Fundus photo: 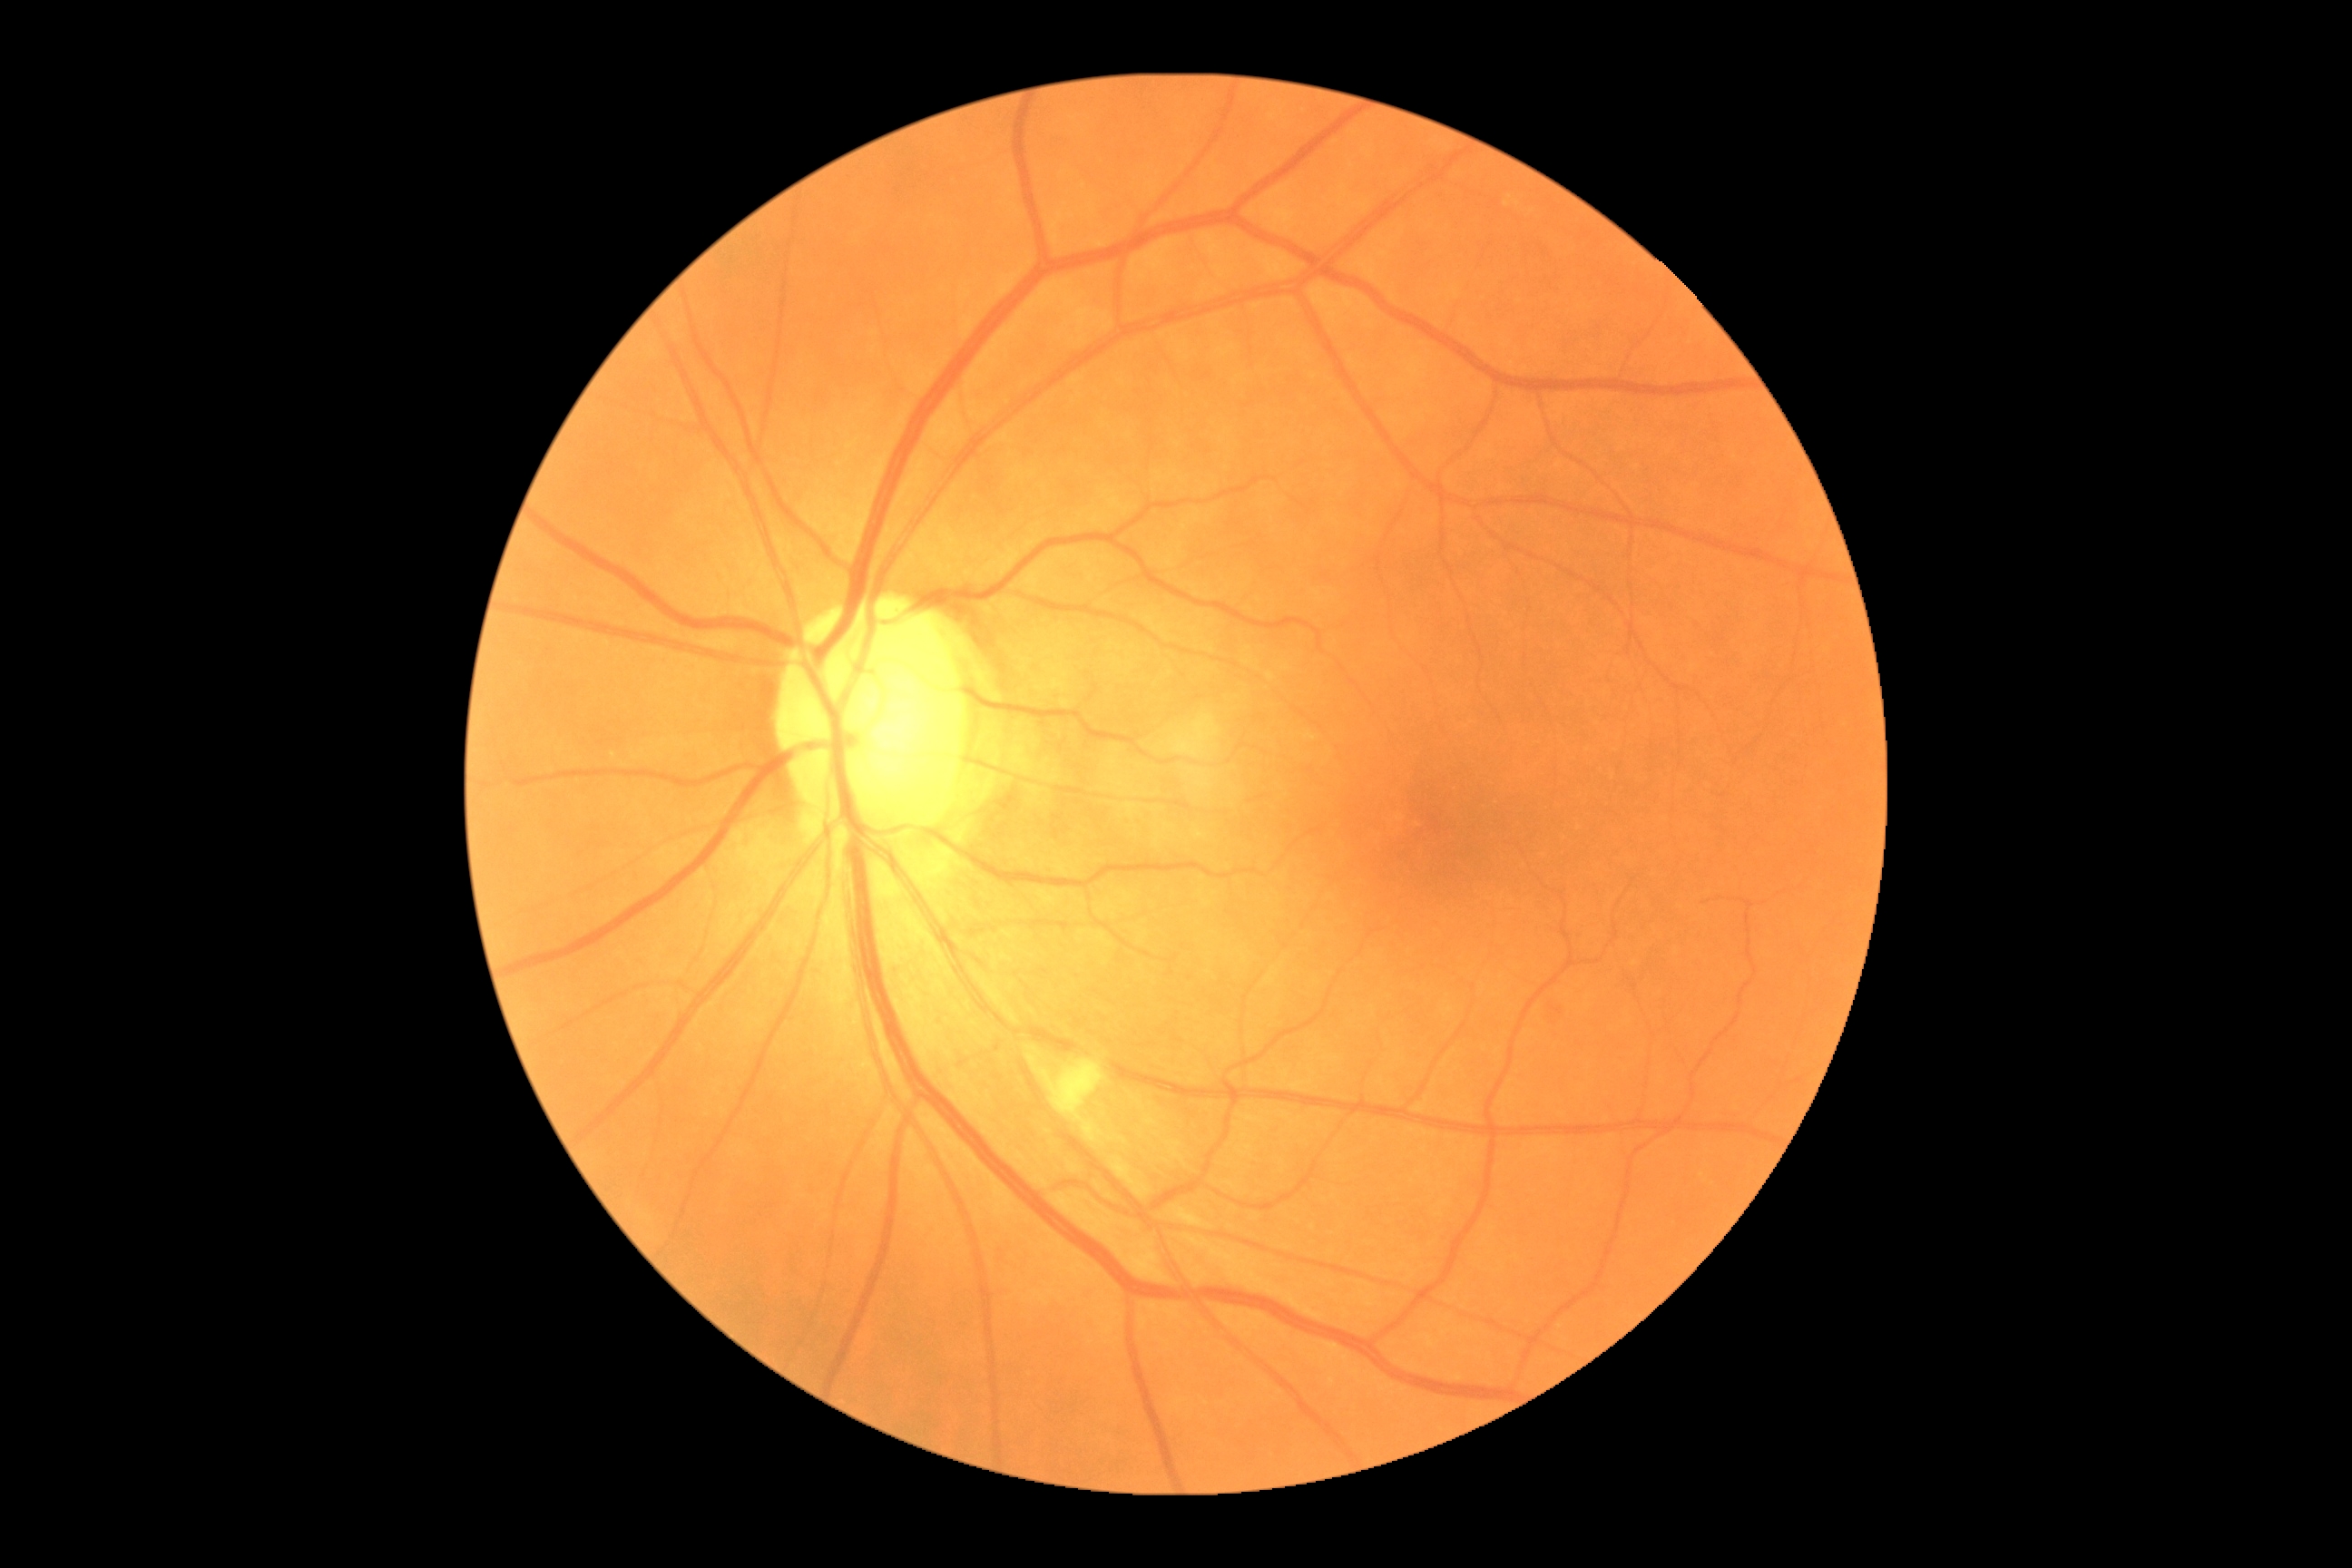

diabetic retinopathy (DR): 2; DR class: non-proliferative diabetic retinopathy.